Non-mydriatic acquisition; camera: Nidek AFC-330; 240x240px: 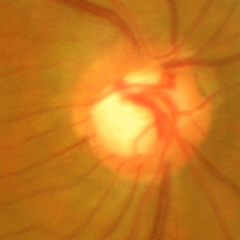

Advanced-stage glaucoma.